Nonmydriatic
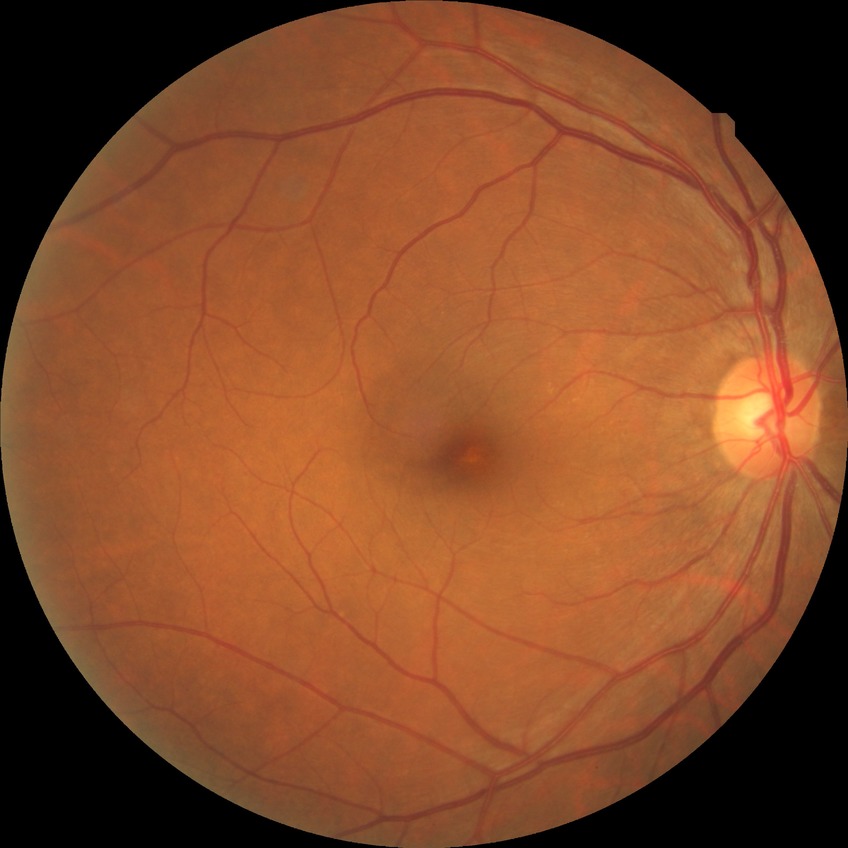
diabetic retinopathy (DR)@NDR (no diabetic retinopathy).